No pharmacologic dilation. Modified Davis classification. Posterior pole color fundus photograph.
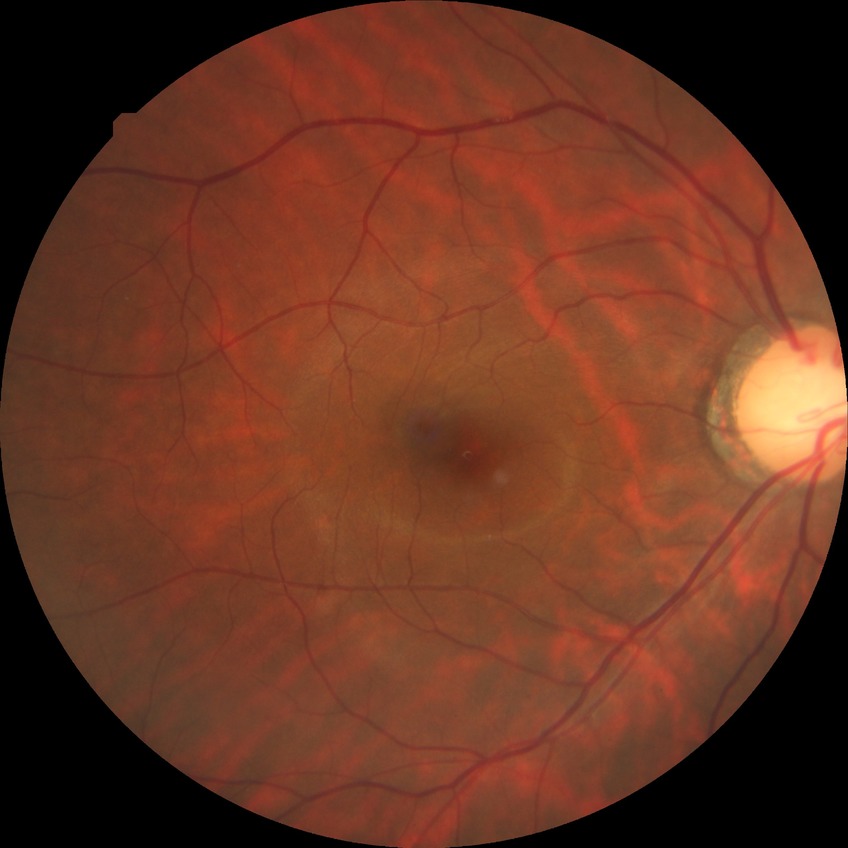 Retinopathy stage: no diabetic retinopathy.